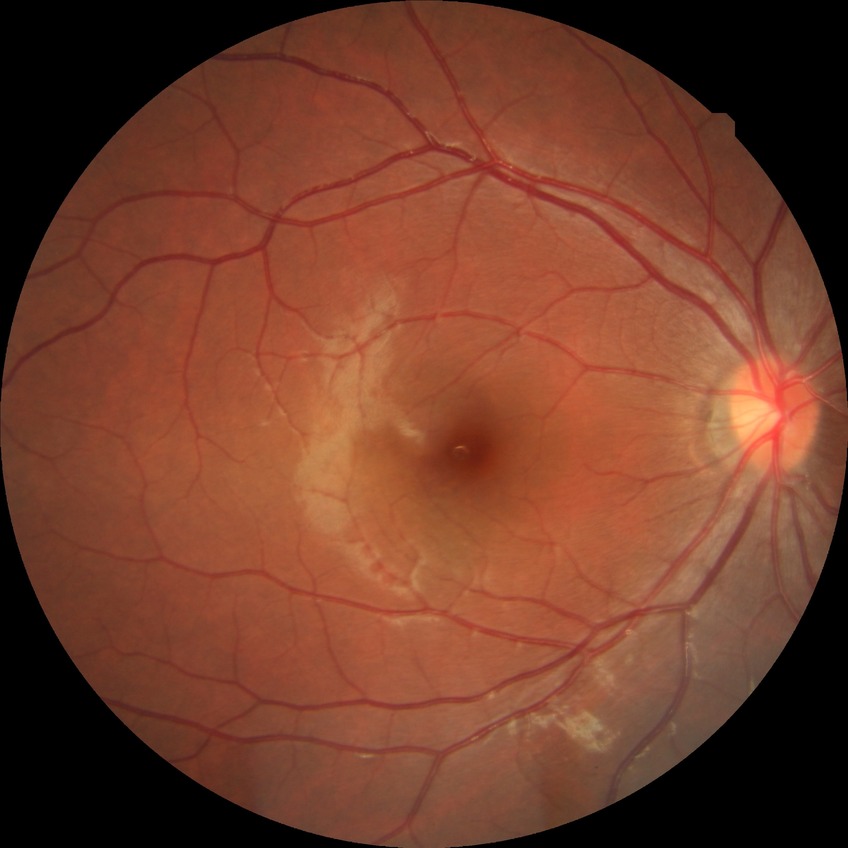
diabetic retinopathy (DR) = no diabetic retinopathy (NDR).